Fundus photo, 2212x1659px
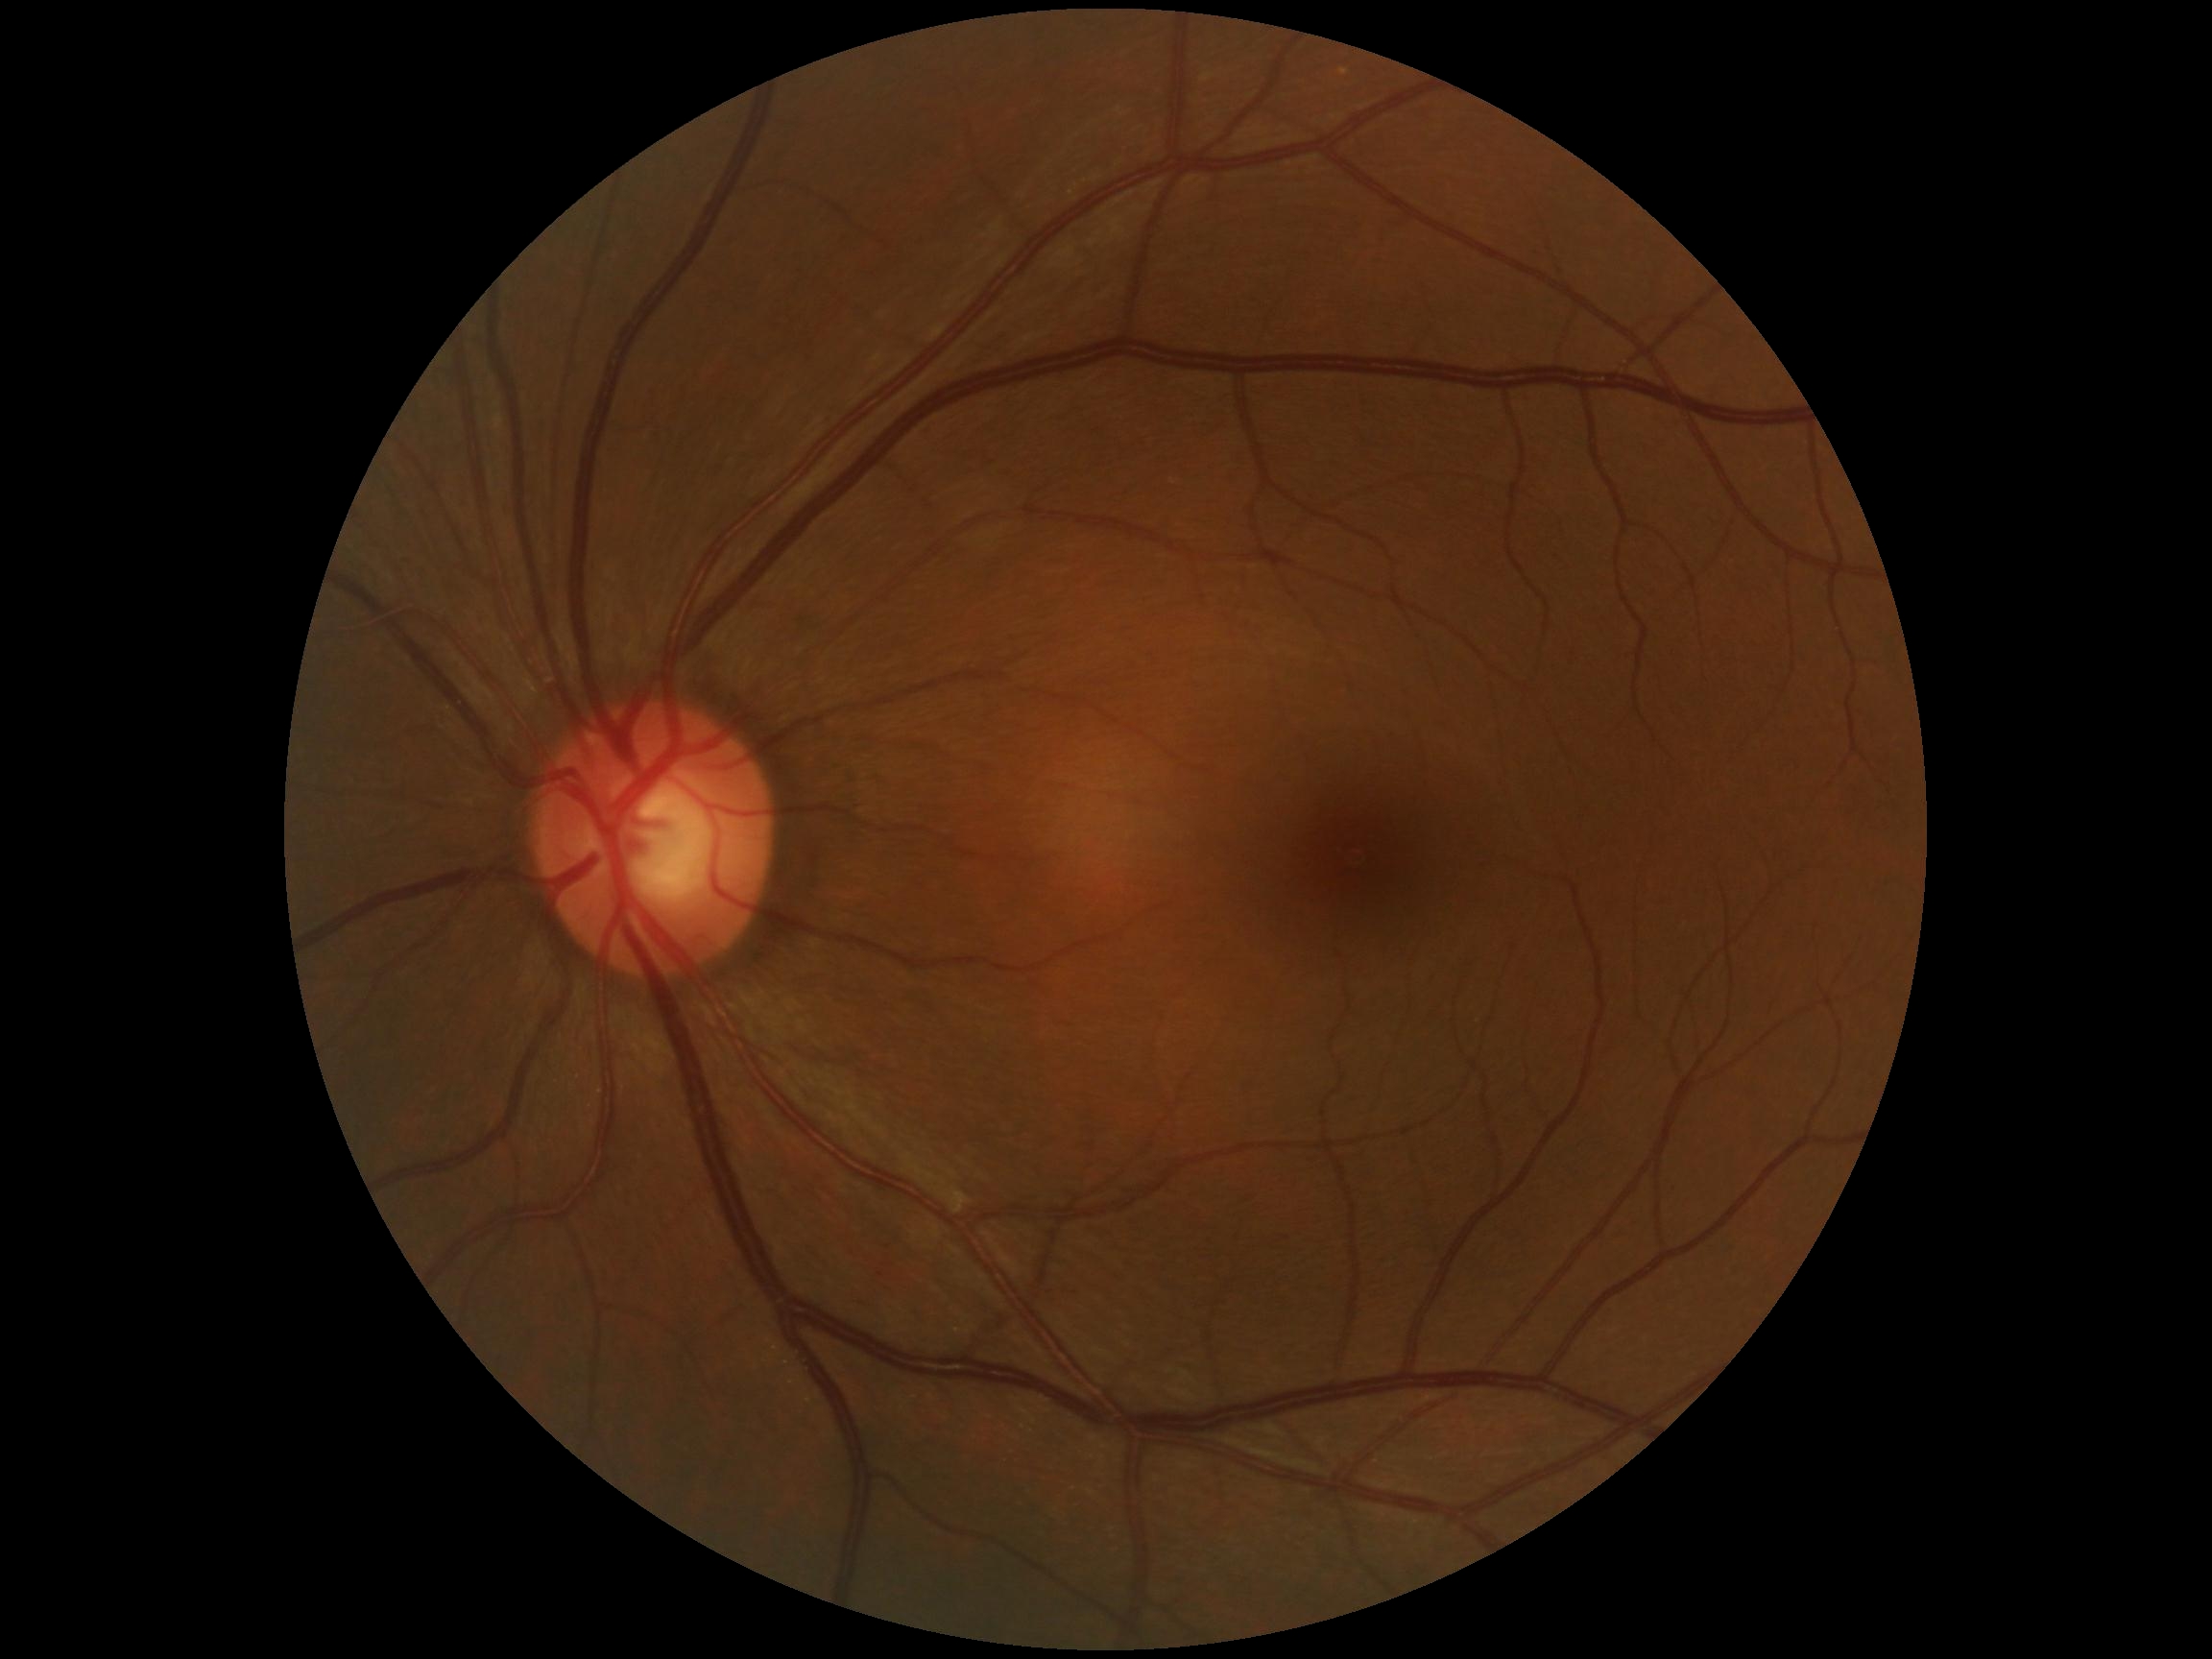

Annotations:
• DR impression — negative for DR
• DR grade — 0 (no apparent retinopathy)